NIDEK AFC-230 · modified Davis grading
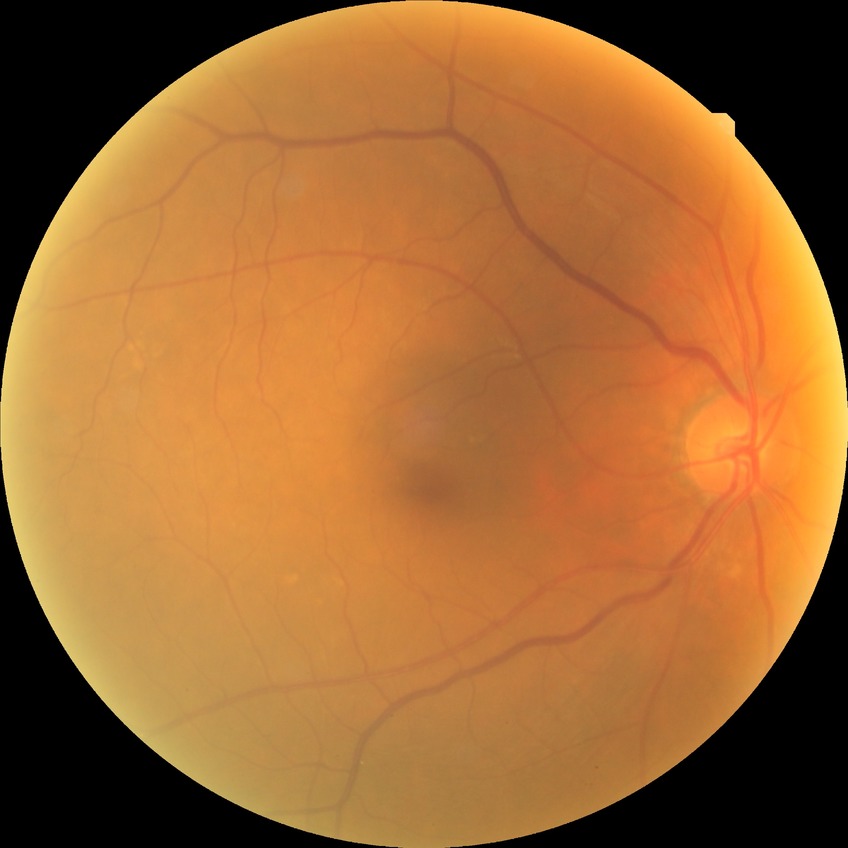

DR impression: no apparent DR; Davis DR grade: NDR.